Posterior pole color fundus photograph; without pupil dilation
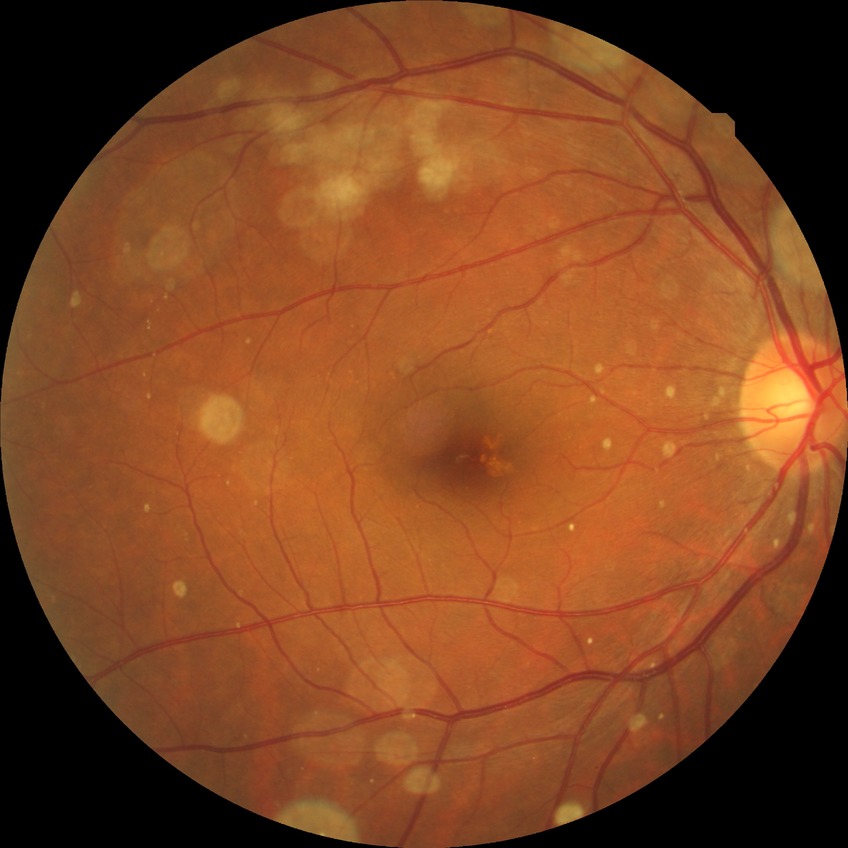
{
  "davis_grade": "no diabetic retinopathy"
}